Without pupil dilation; retinal fundus photograph: 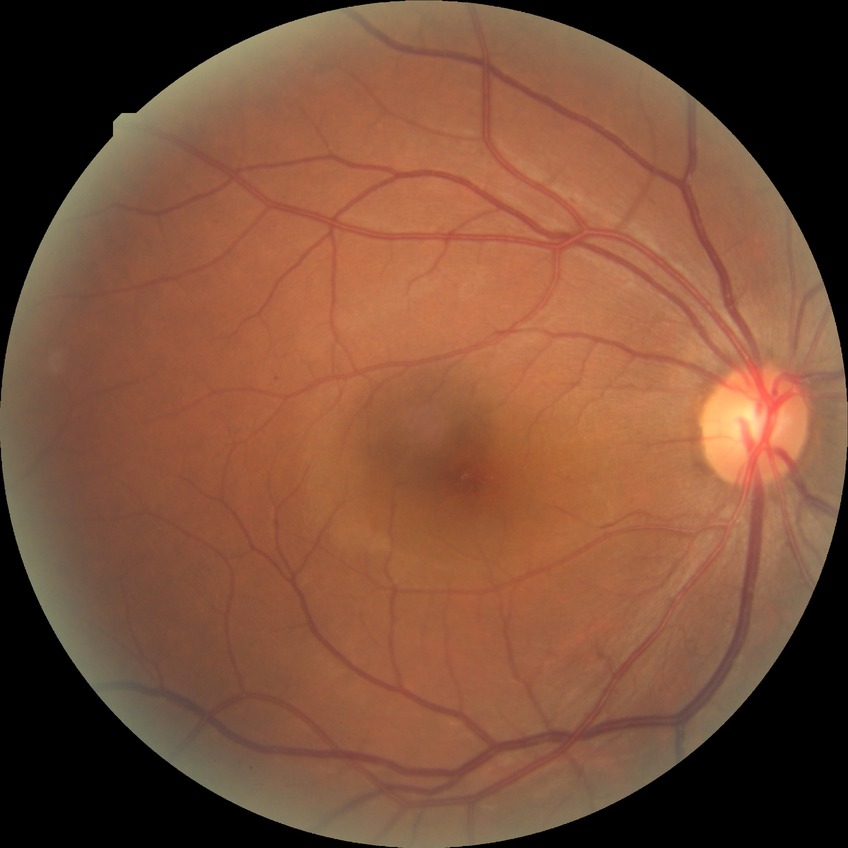

Diabetic retinopathy (DR): simple diabetic retinopathy (SDR).
DR class: non-proliferative diabetic retinopathy.